DR severity per modified Davis staging:
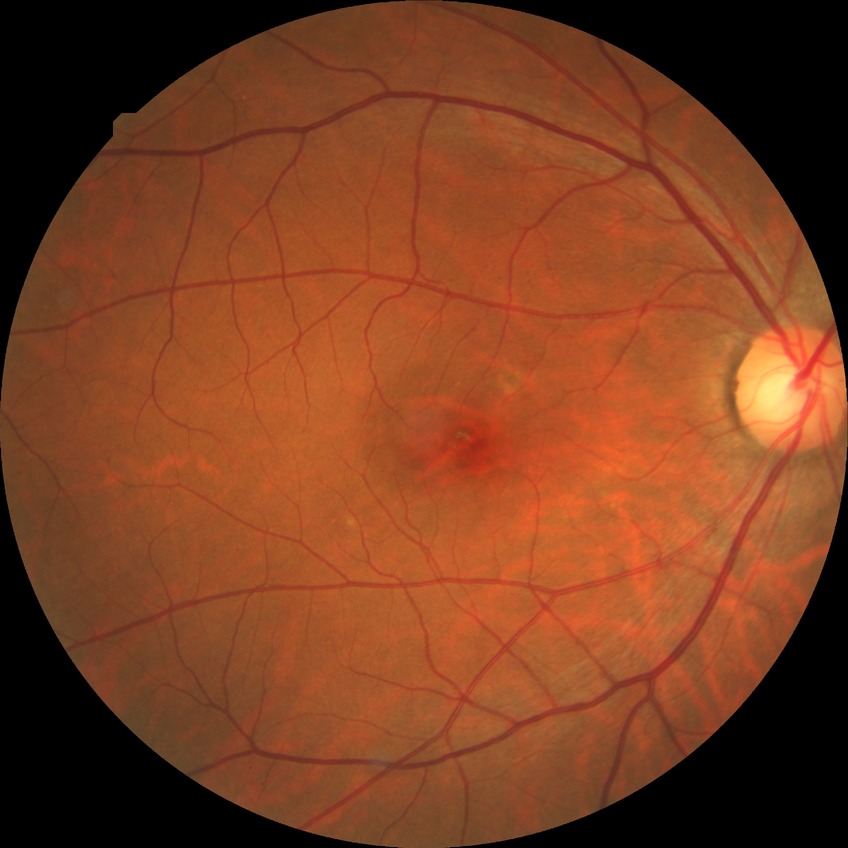
Diabetic retinopathy (DR): no diabetic retinopathy (NDR).